Fundus photo.
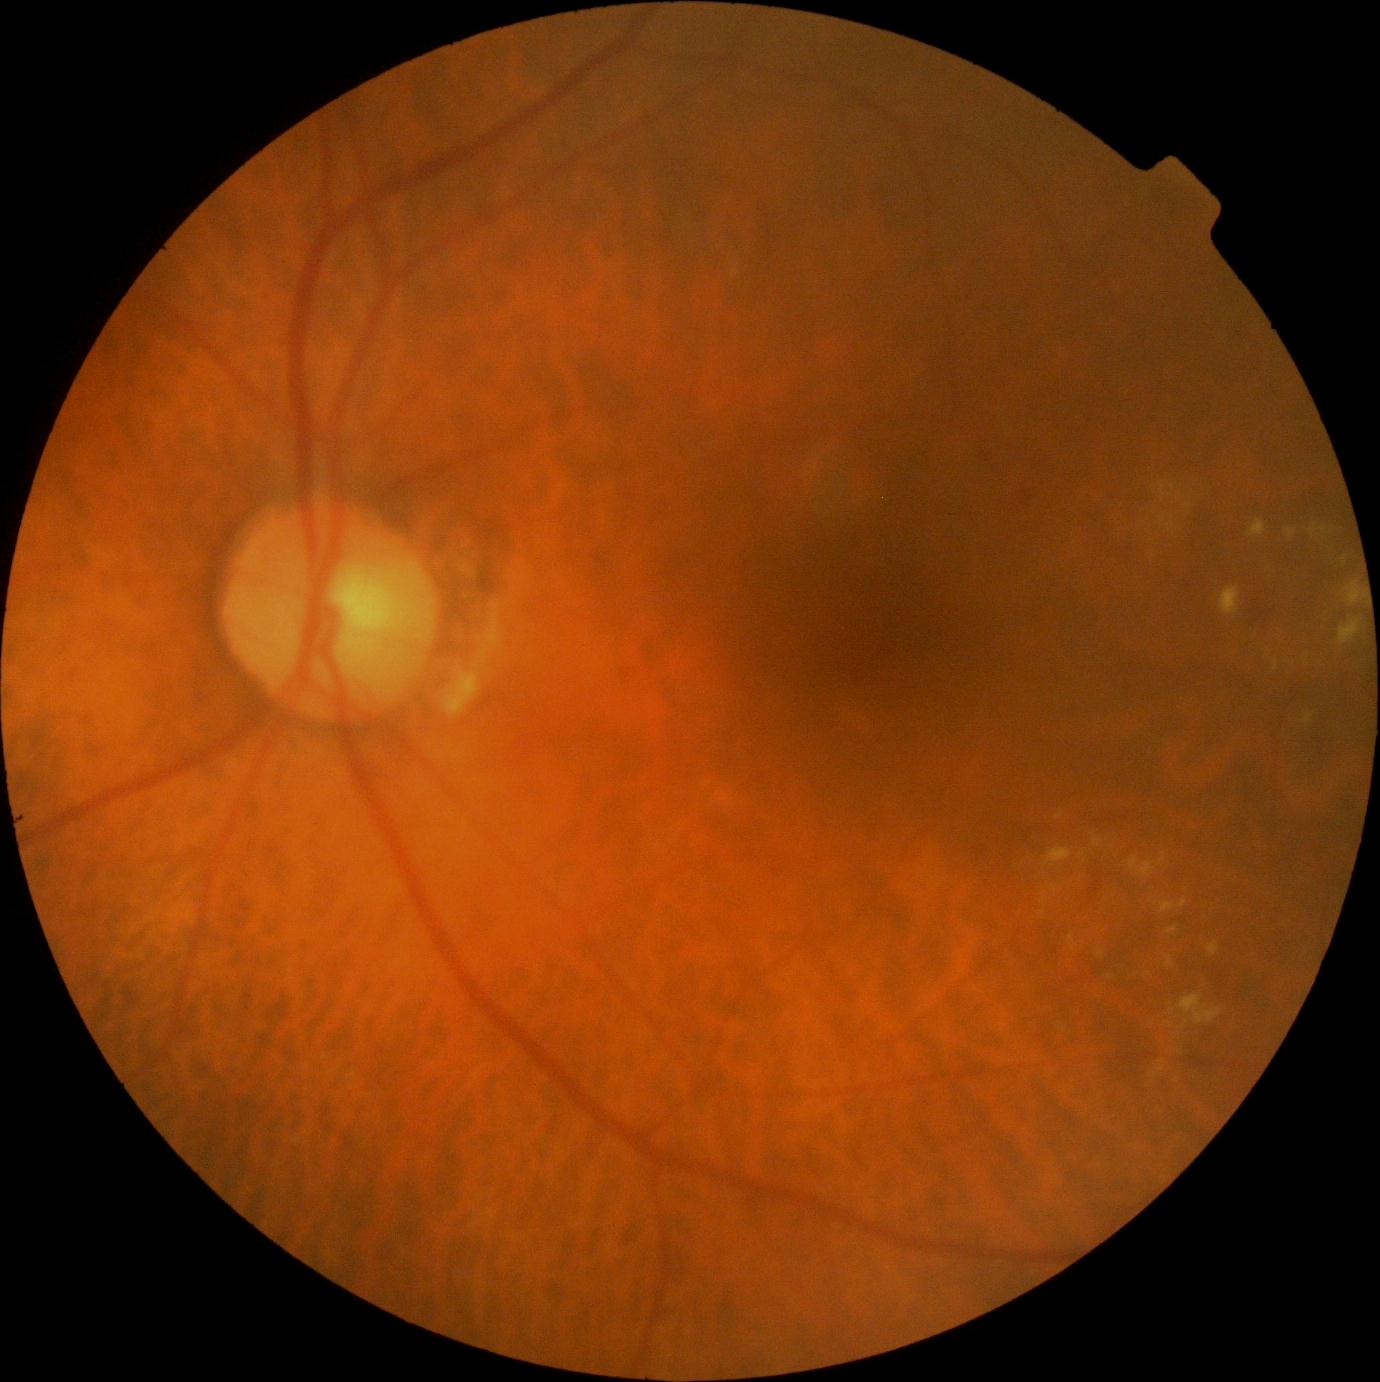
Diabetic retinopathy (DR): 2/4.